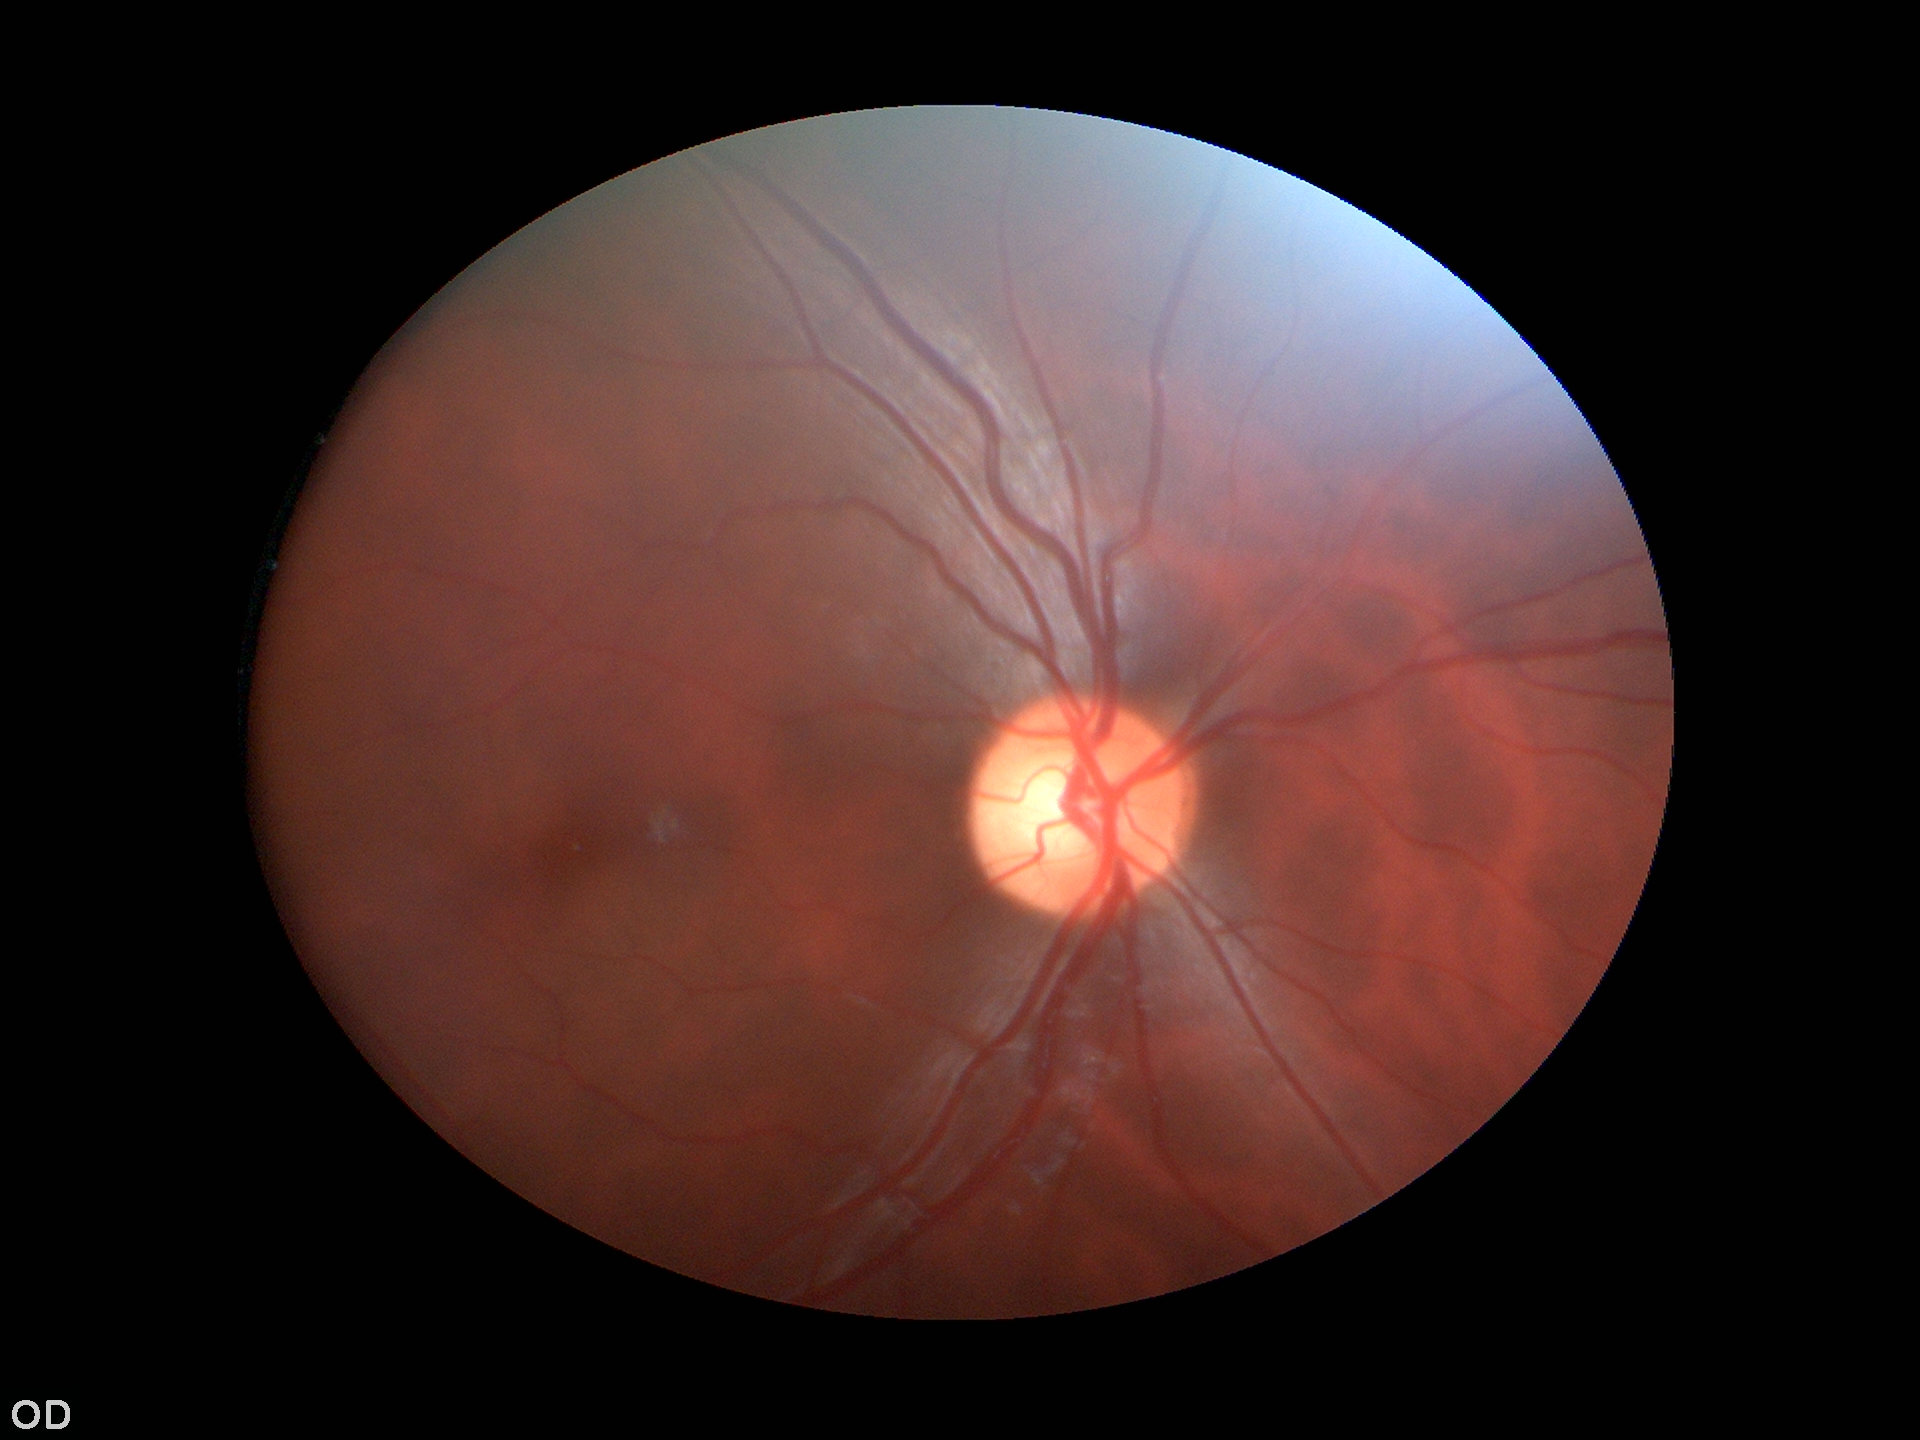 Glaucoma screening = not suspect
vertical cup-disc ratio (VCDR) = 0.54